Modified Davis grading:
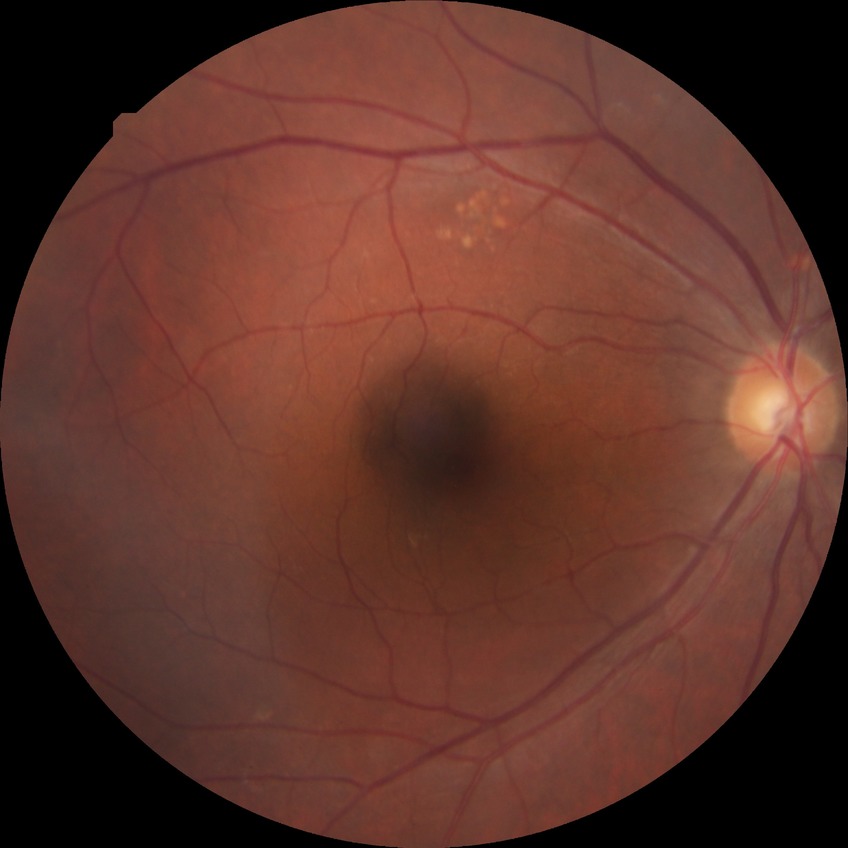 diabetic retinopathy (DR)@NDR (no diabetic retinopathy).